FOV: 200 degrees · 1924 by 1556 pixels · wide-field retinal mosaic image — 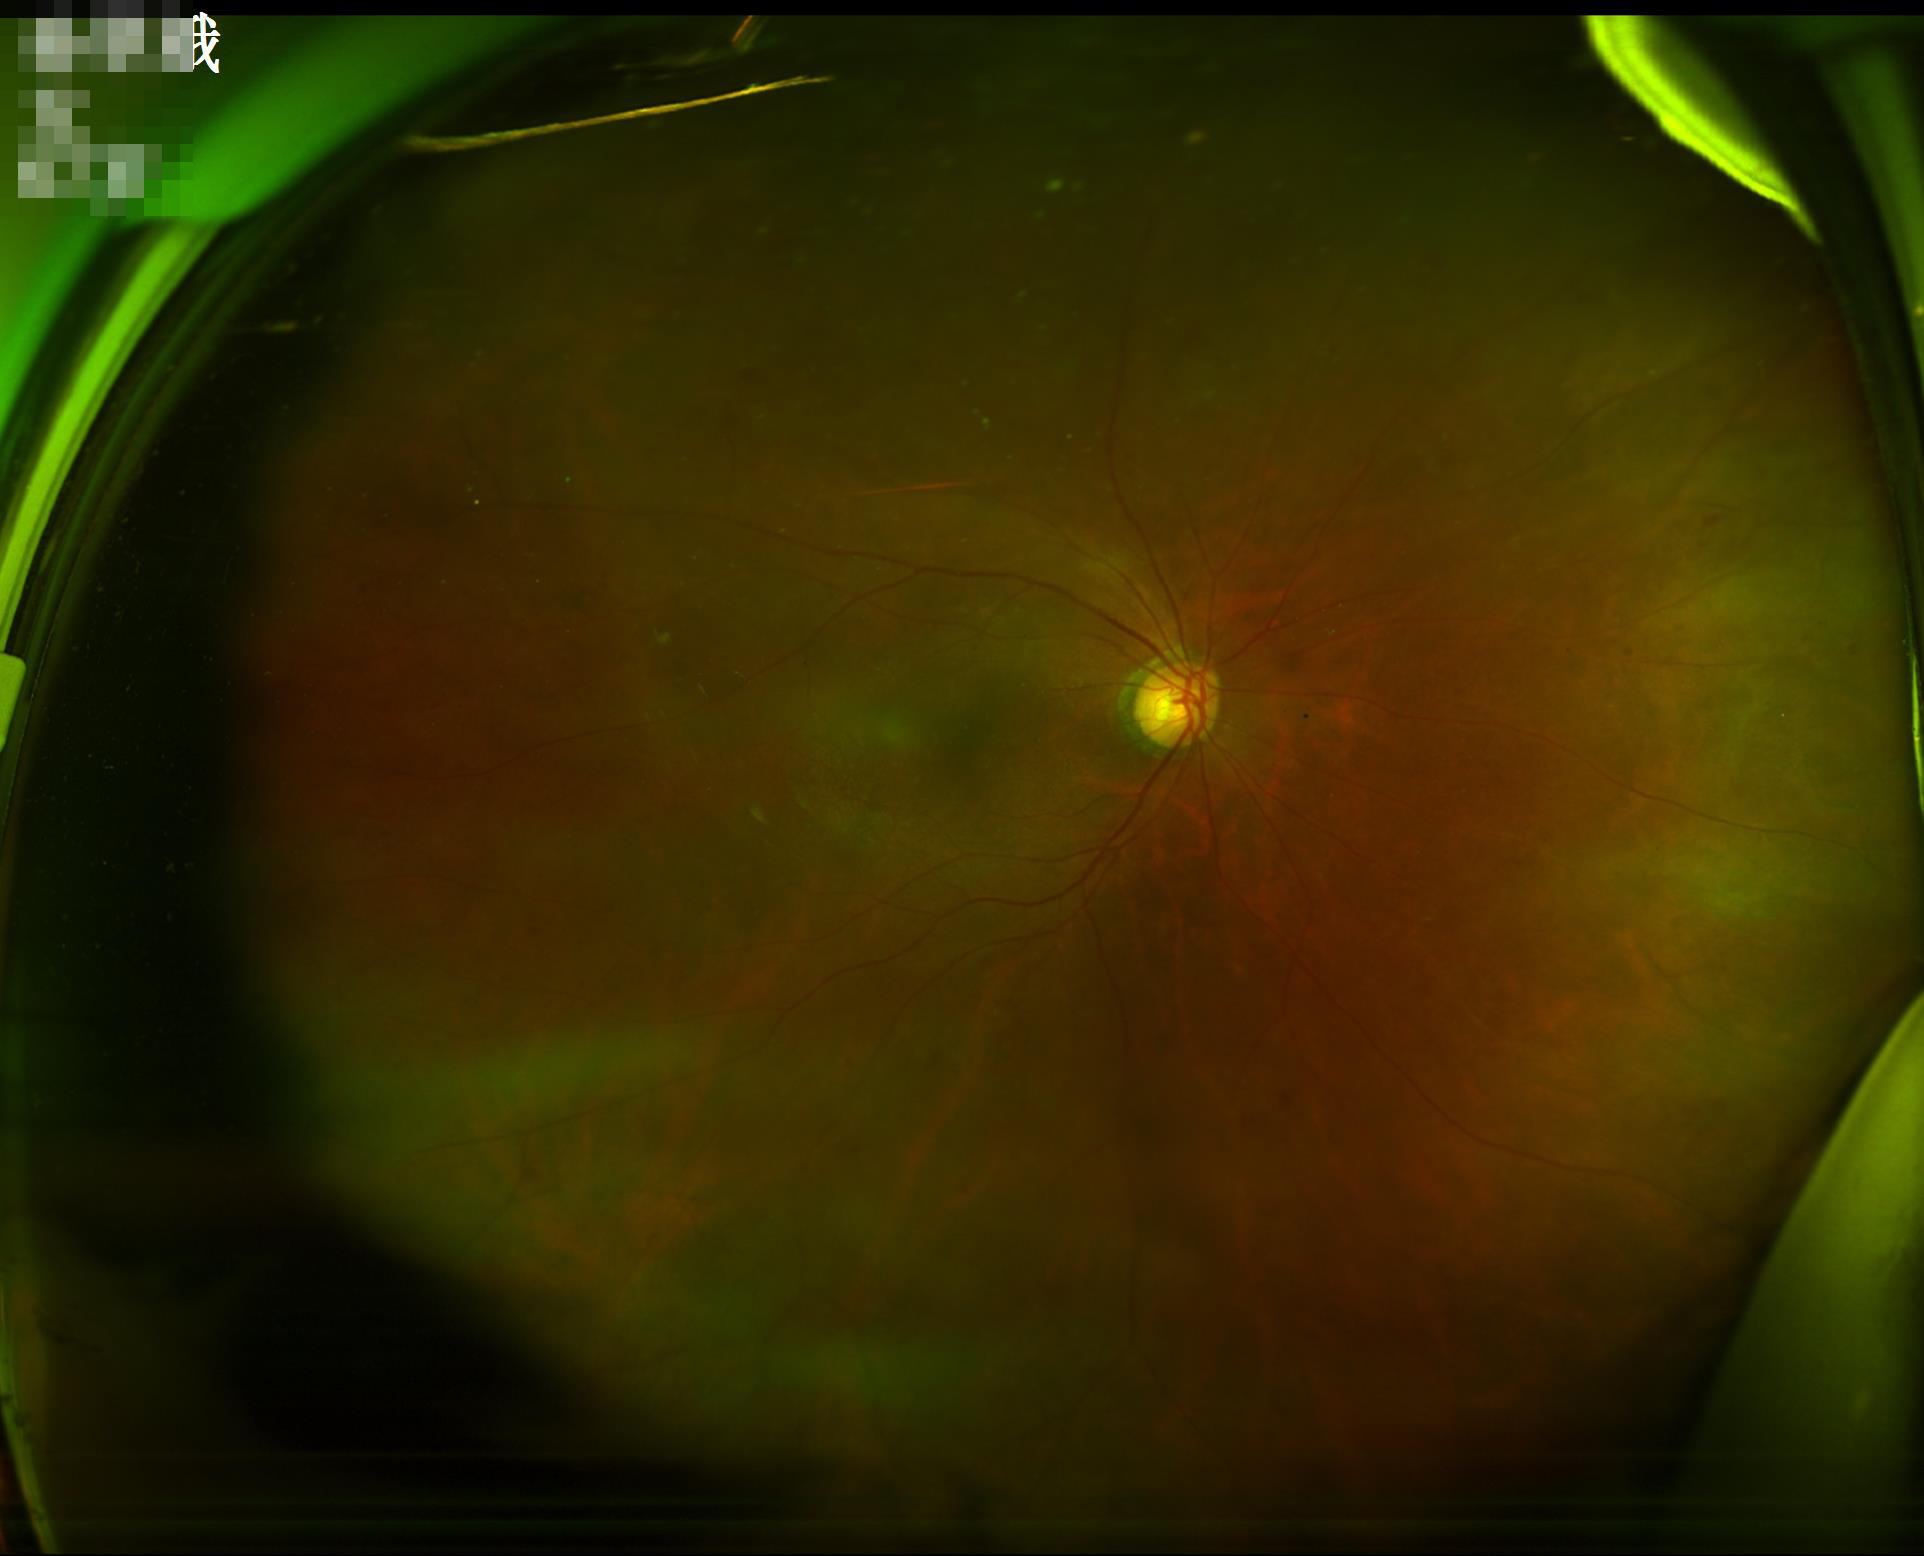
There is over- or under-exposure or a color cast.
Image quality is suboptimal.
Optic disc, vessels, and background are in focus.